2352x1568px · FOV: 45 degrees · CFP
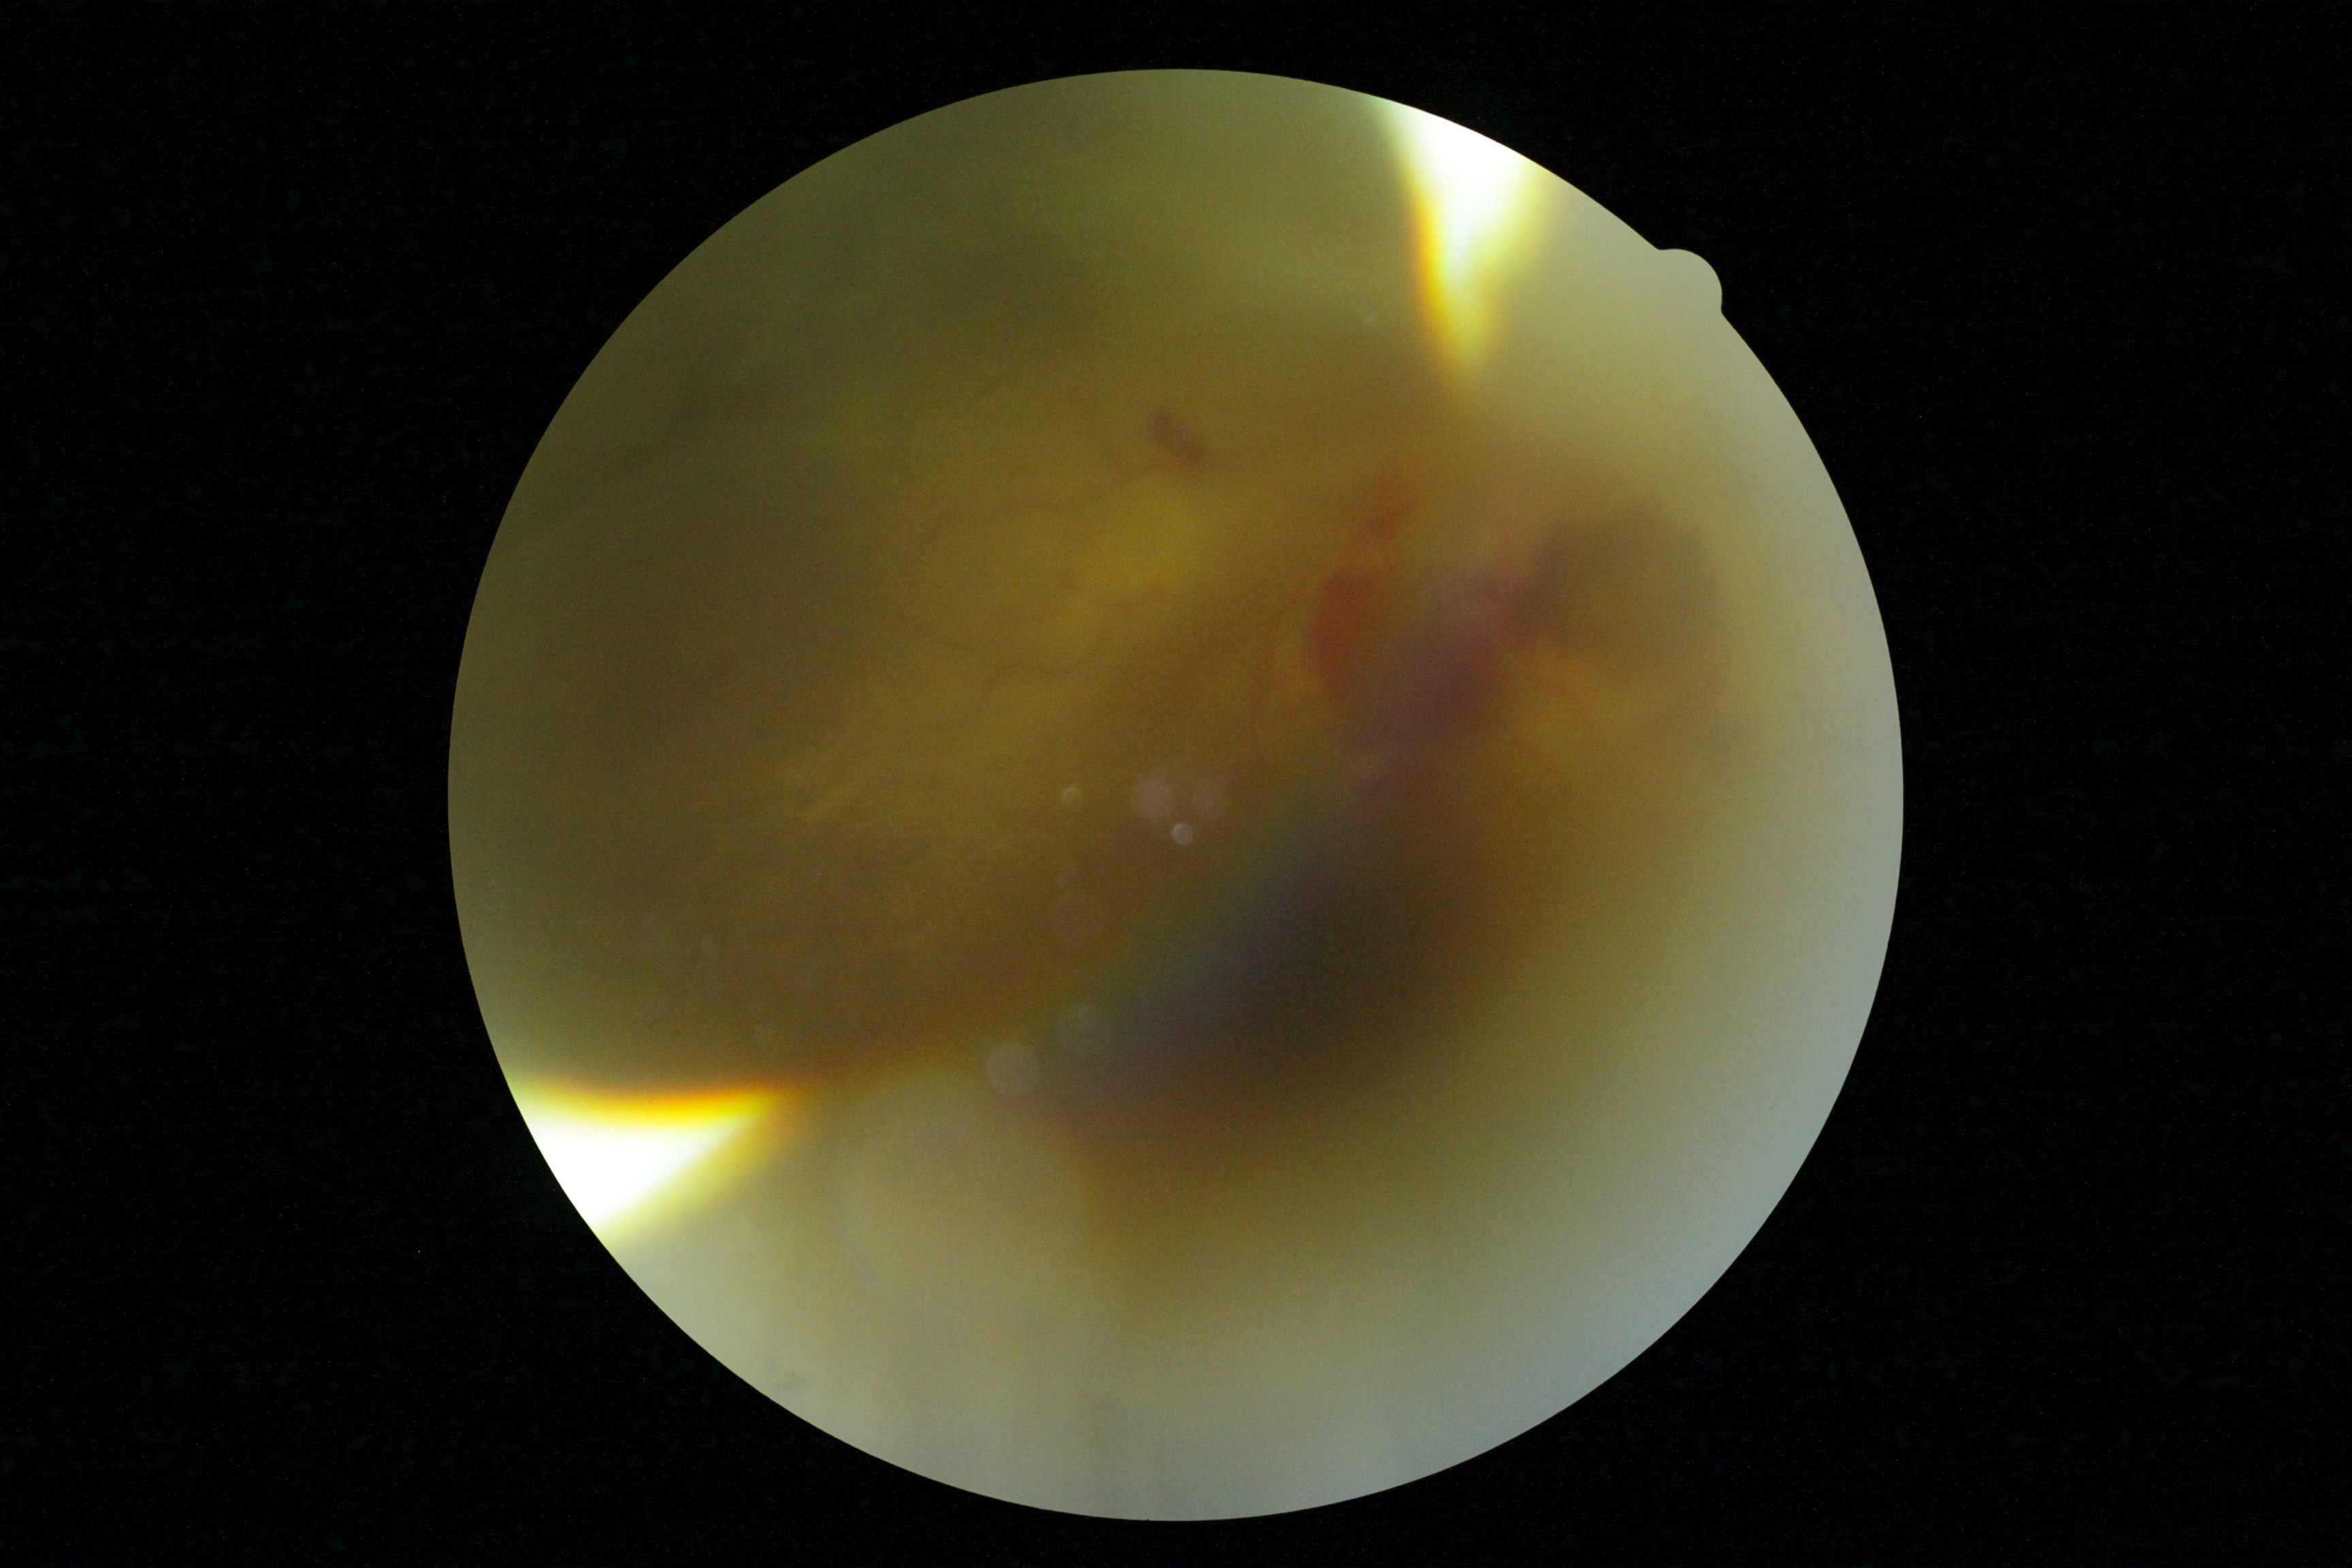
diabetic retinopathy: PDR (grade 4).